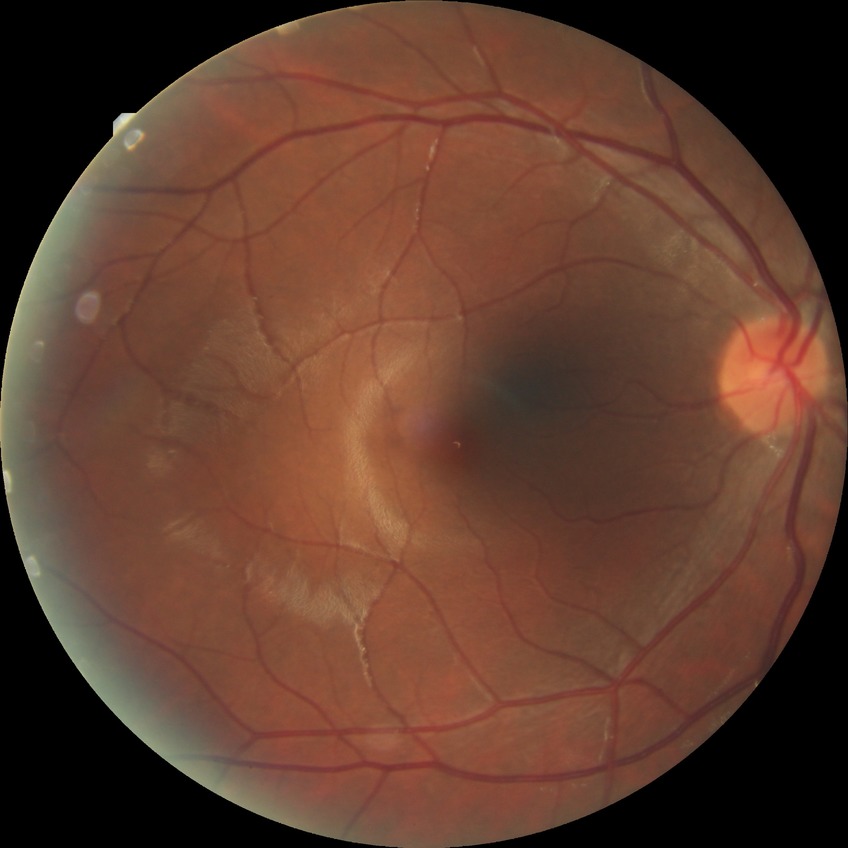
diabetic retinopathy (DR)=NDR (no diabetic retinopathy).